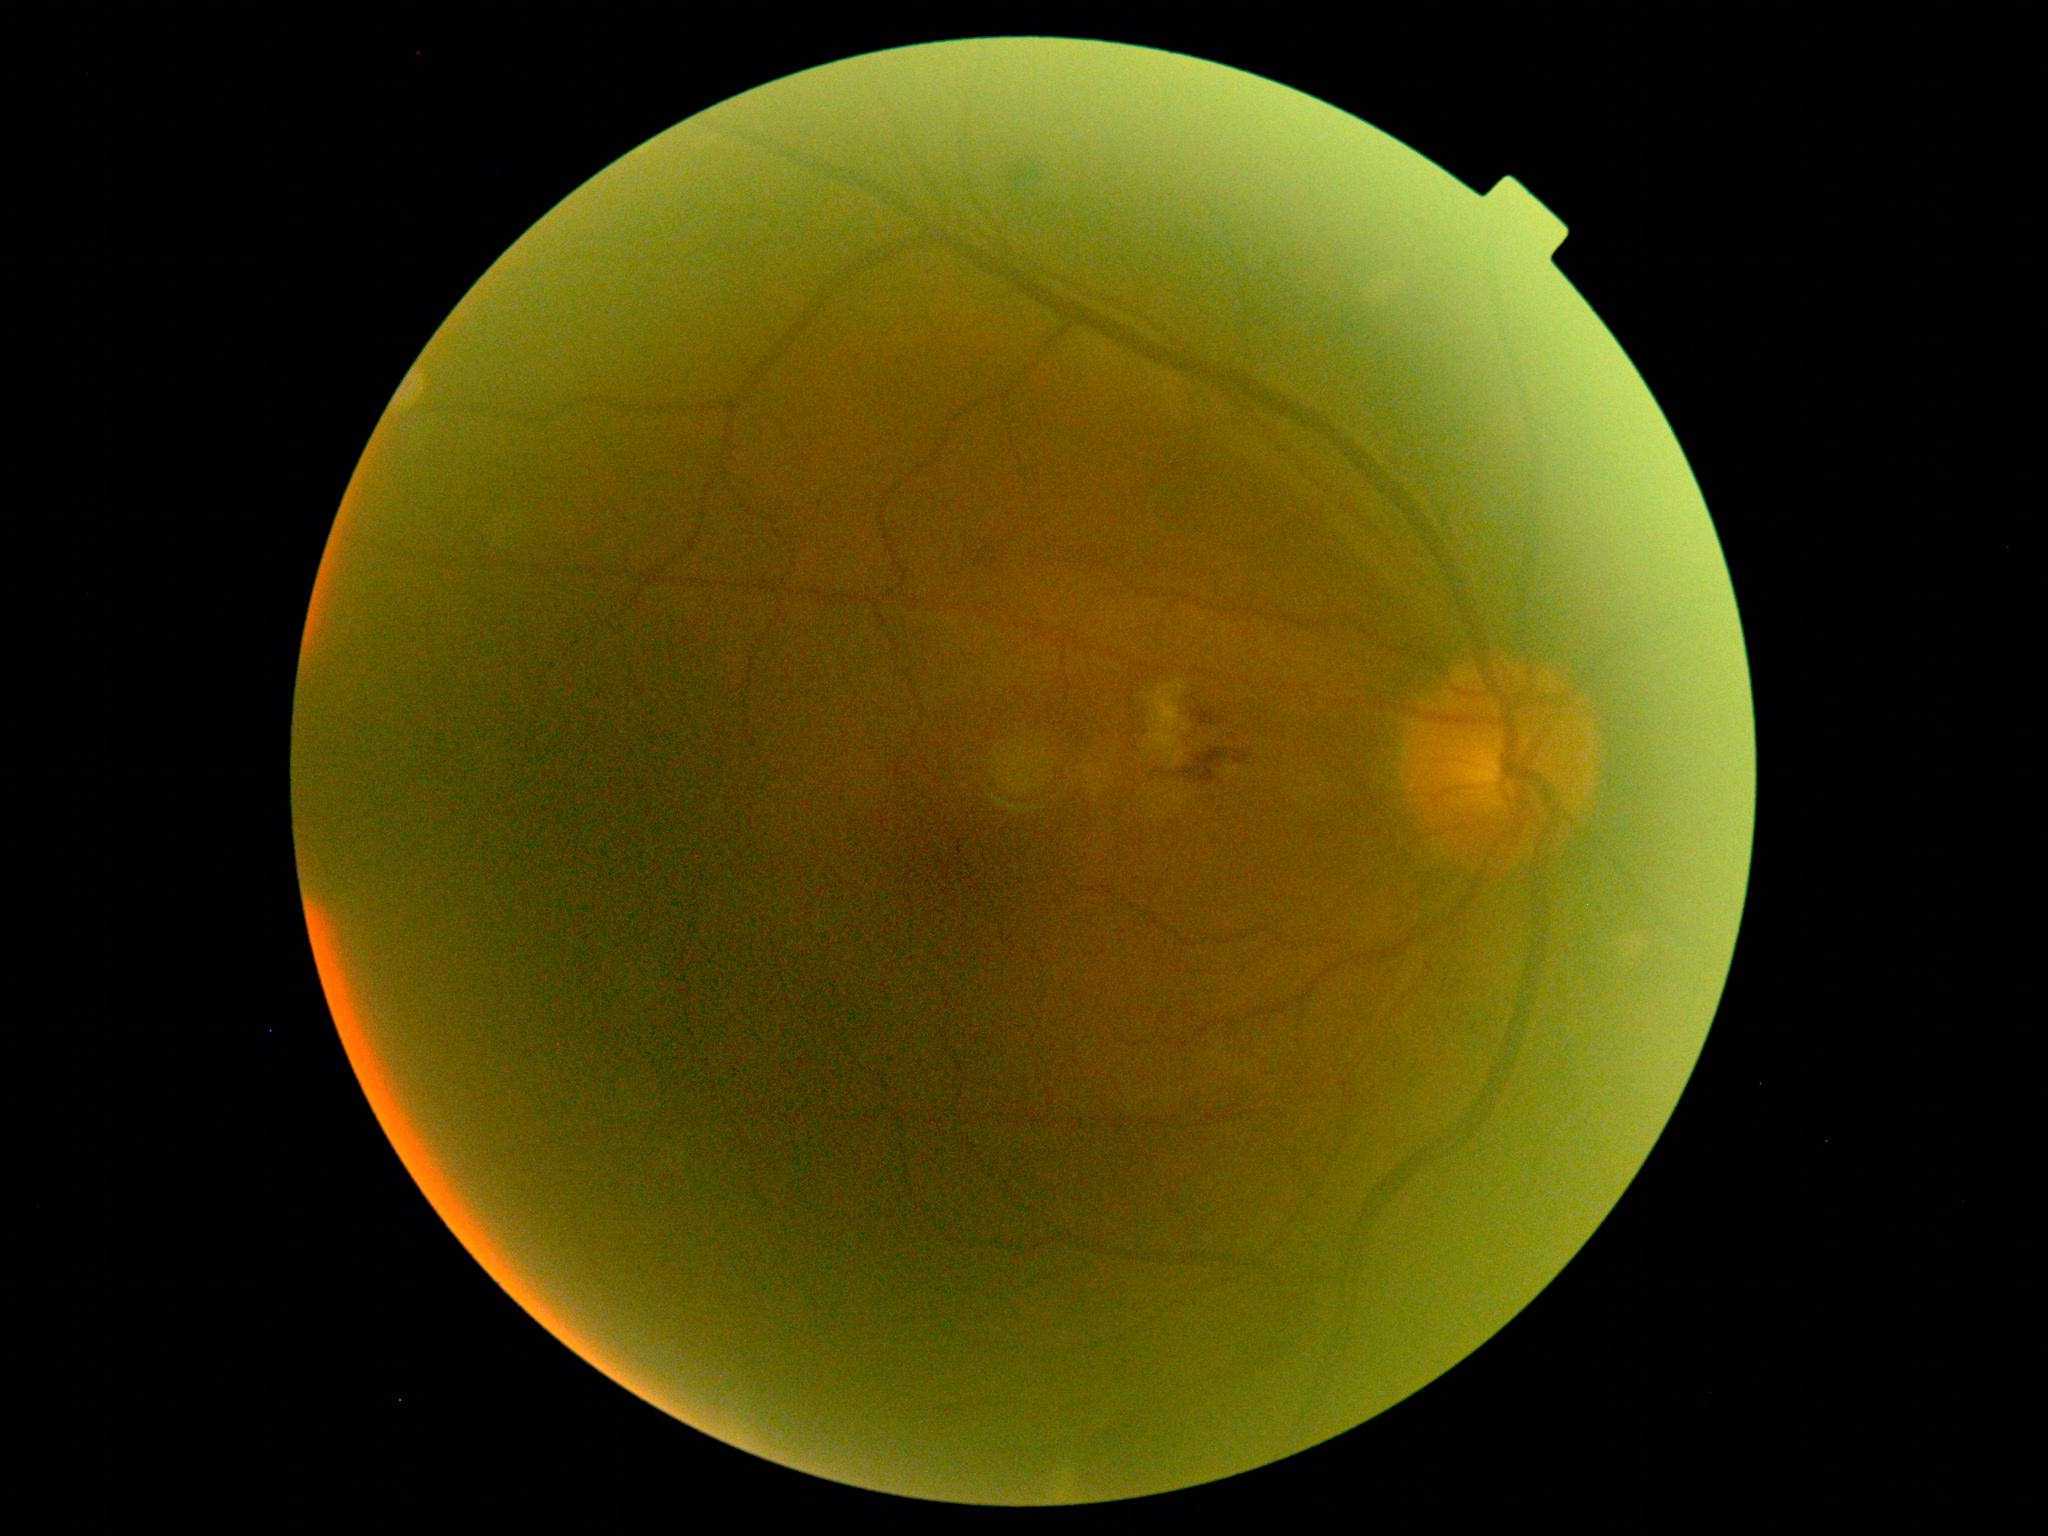
DR@moderate NPDR (grade 2).